NIDEK AFC-230 · image size 848x848 · 45° FOV · no pharmacologic dilation · posterior pole photograph: 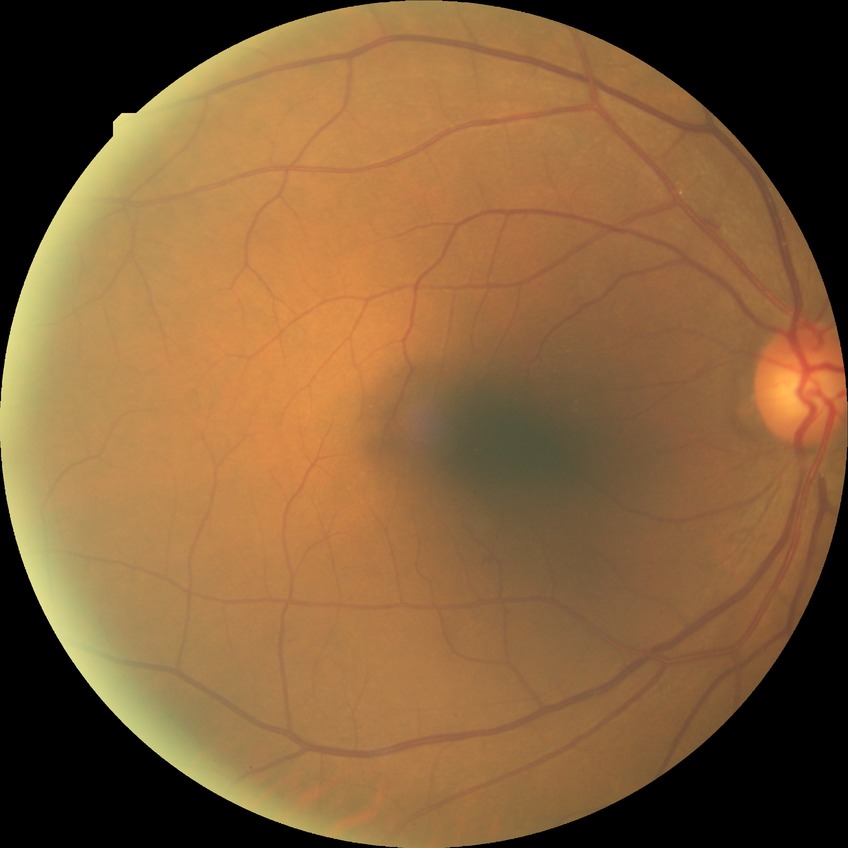 Modified Davis grading is no diabetic retinopathy.